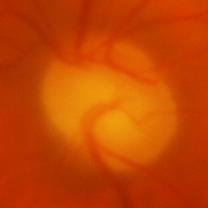 Q: Is glaucoma present?
A: Yes — glaucoma.